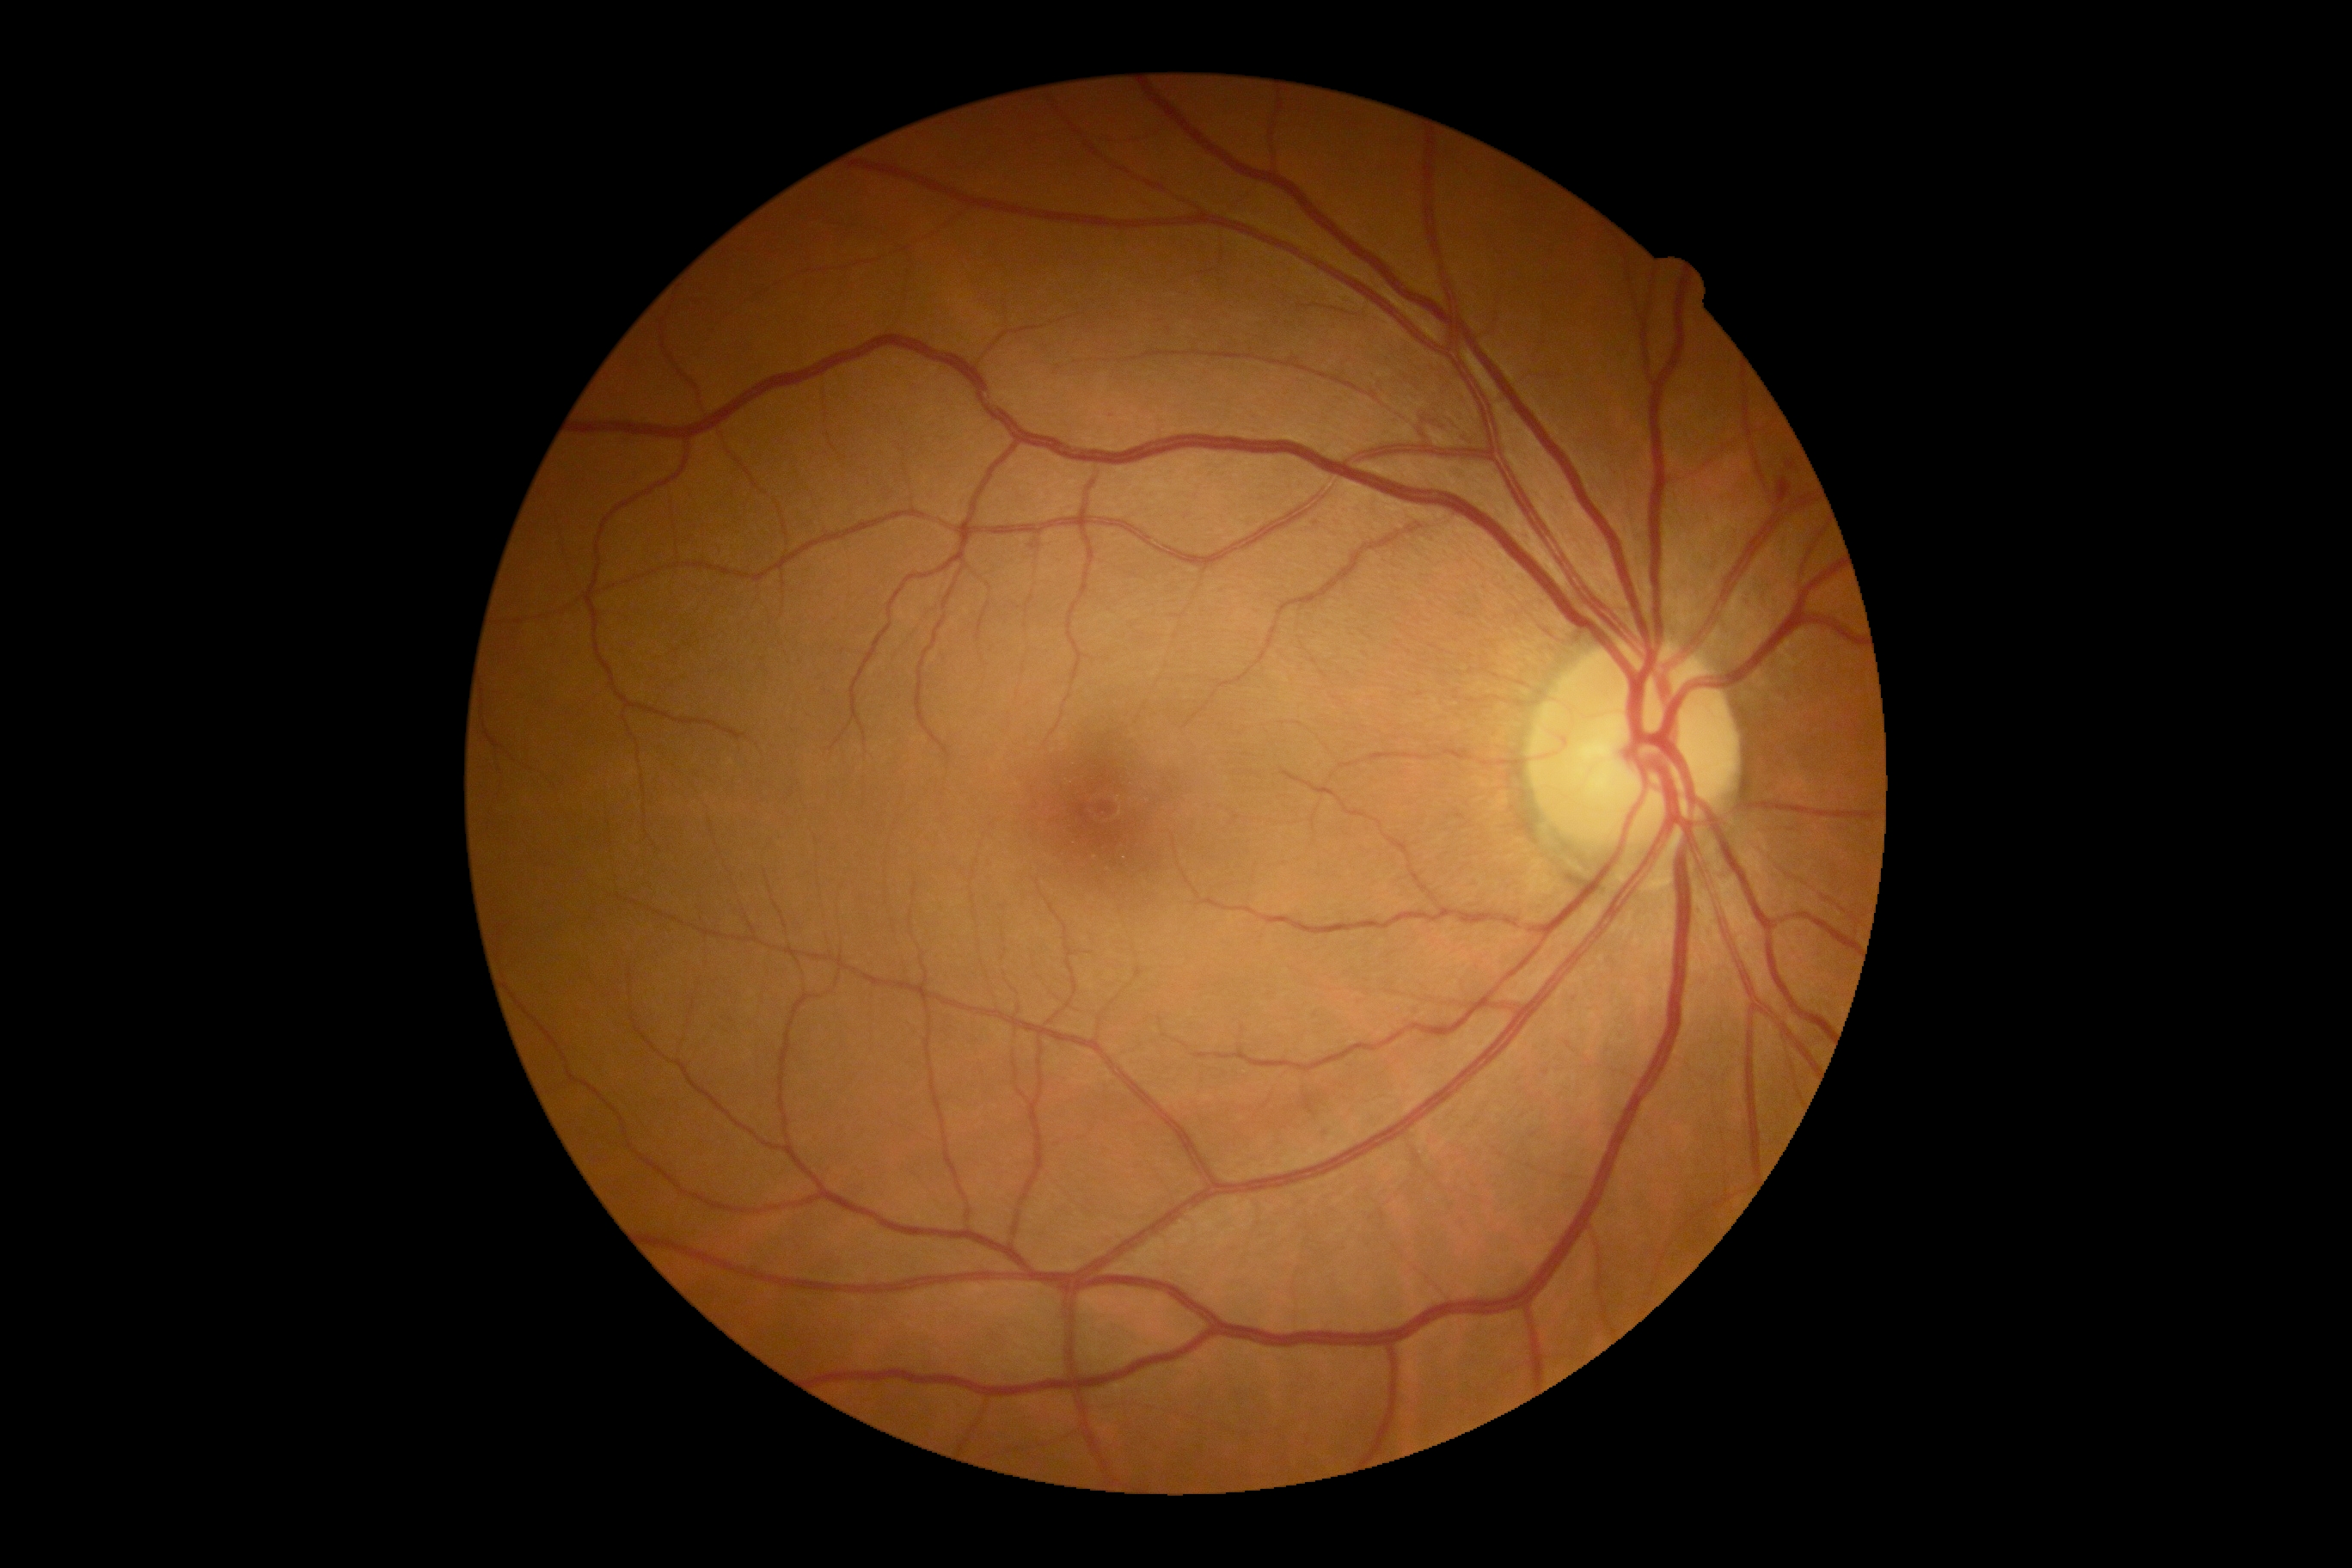
{
  "dr_grade": "grade 2 (moderate NPDR)"
}